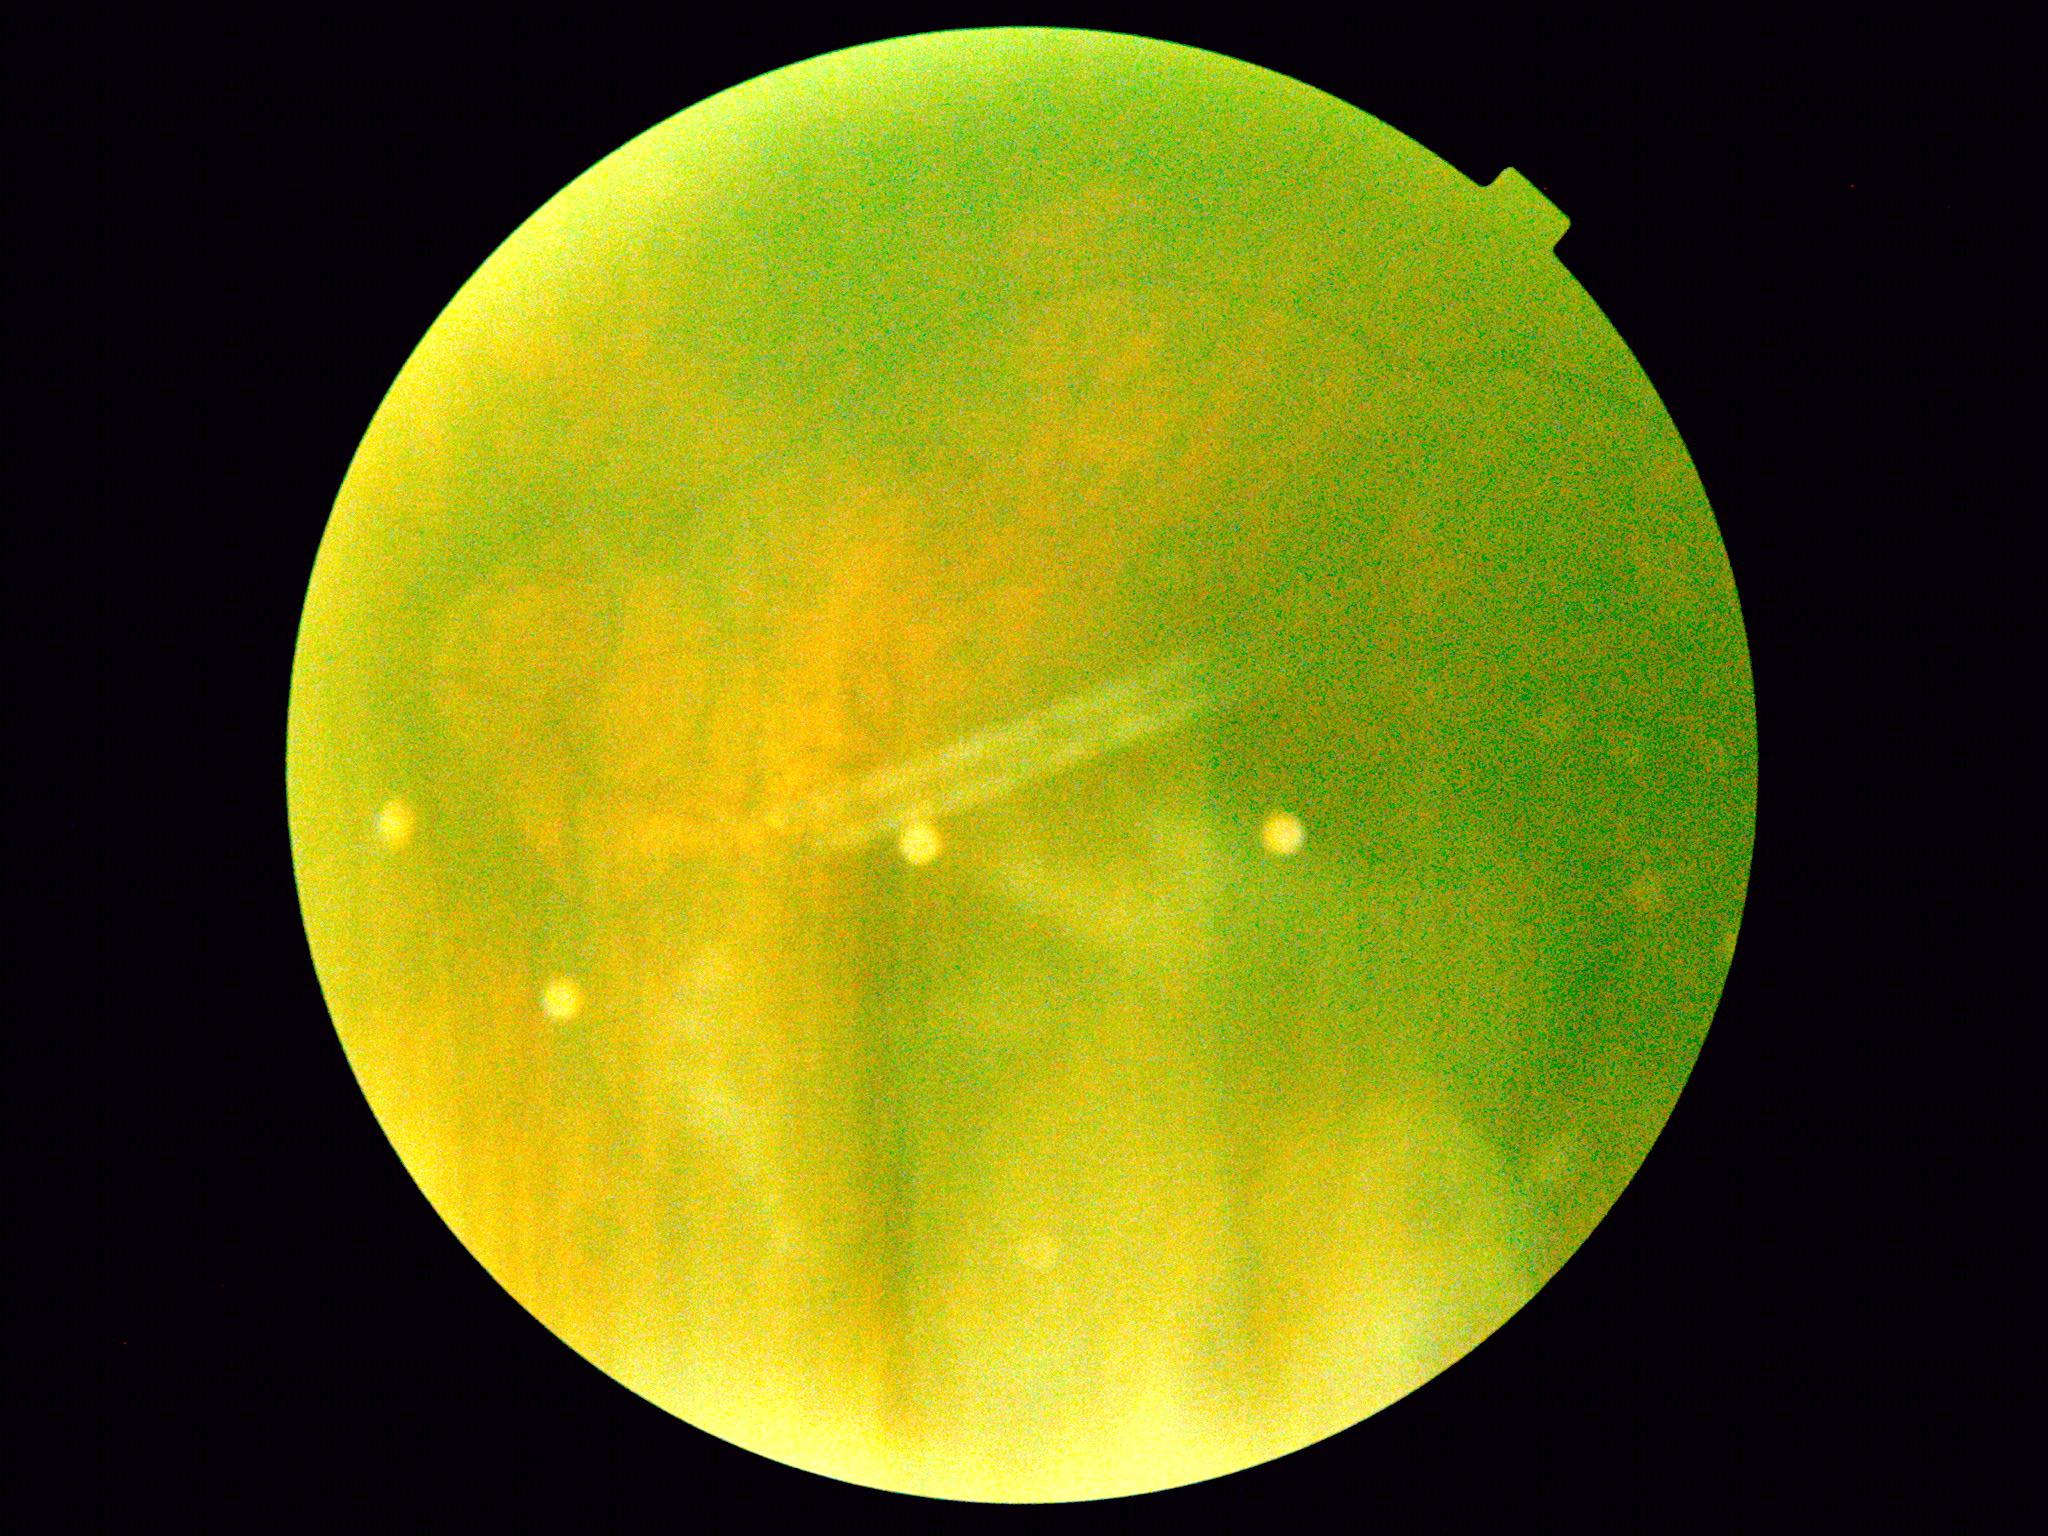

Quality too poor to assess for DR. Retinopathy grade: ungradable.